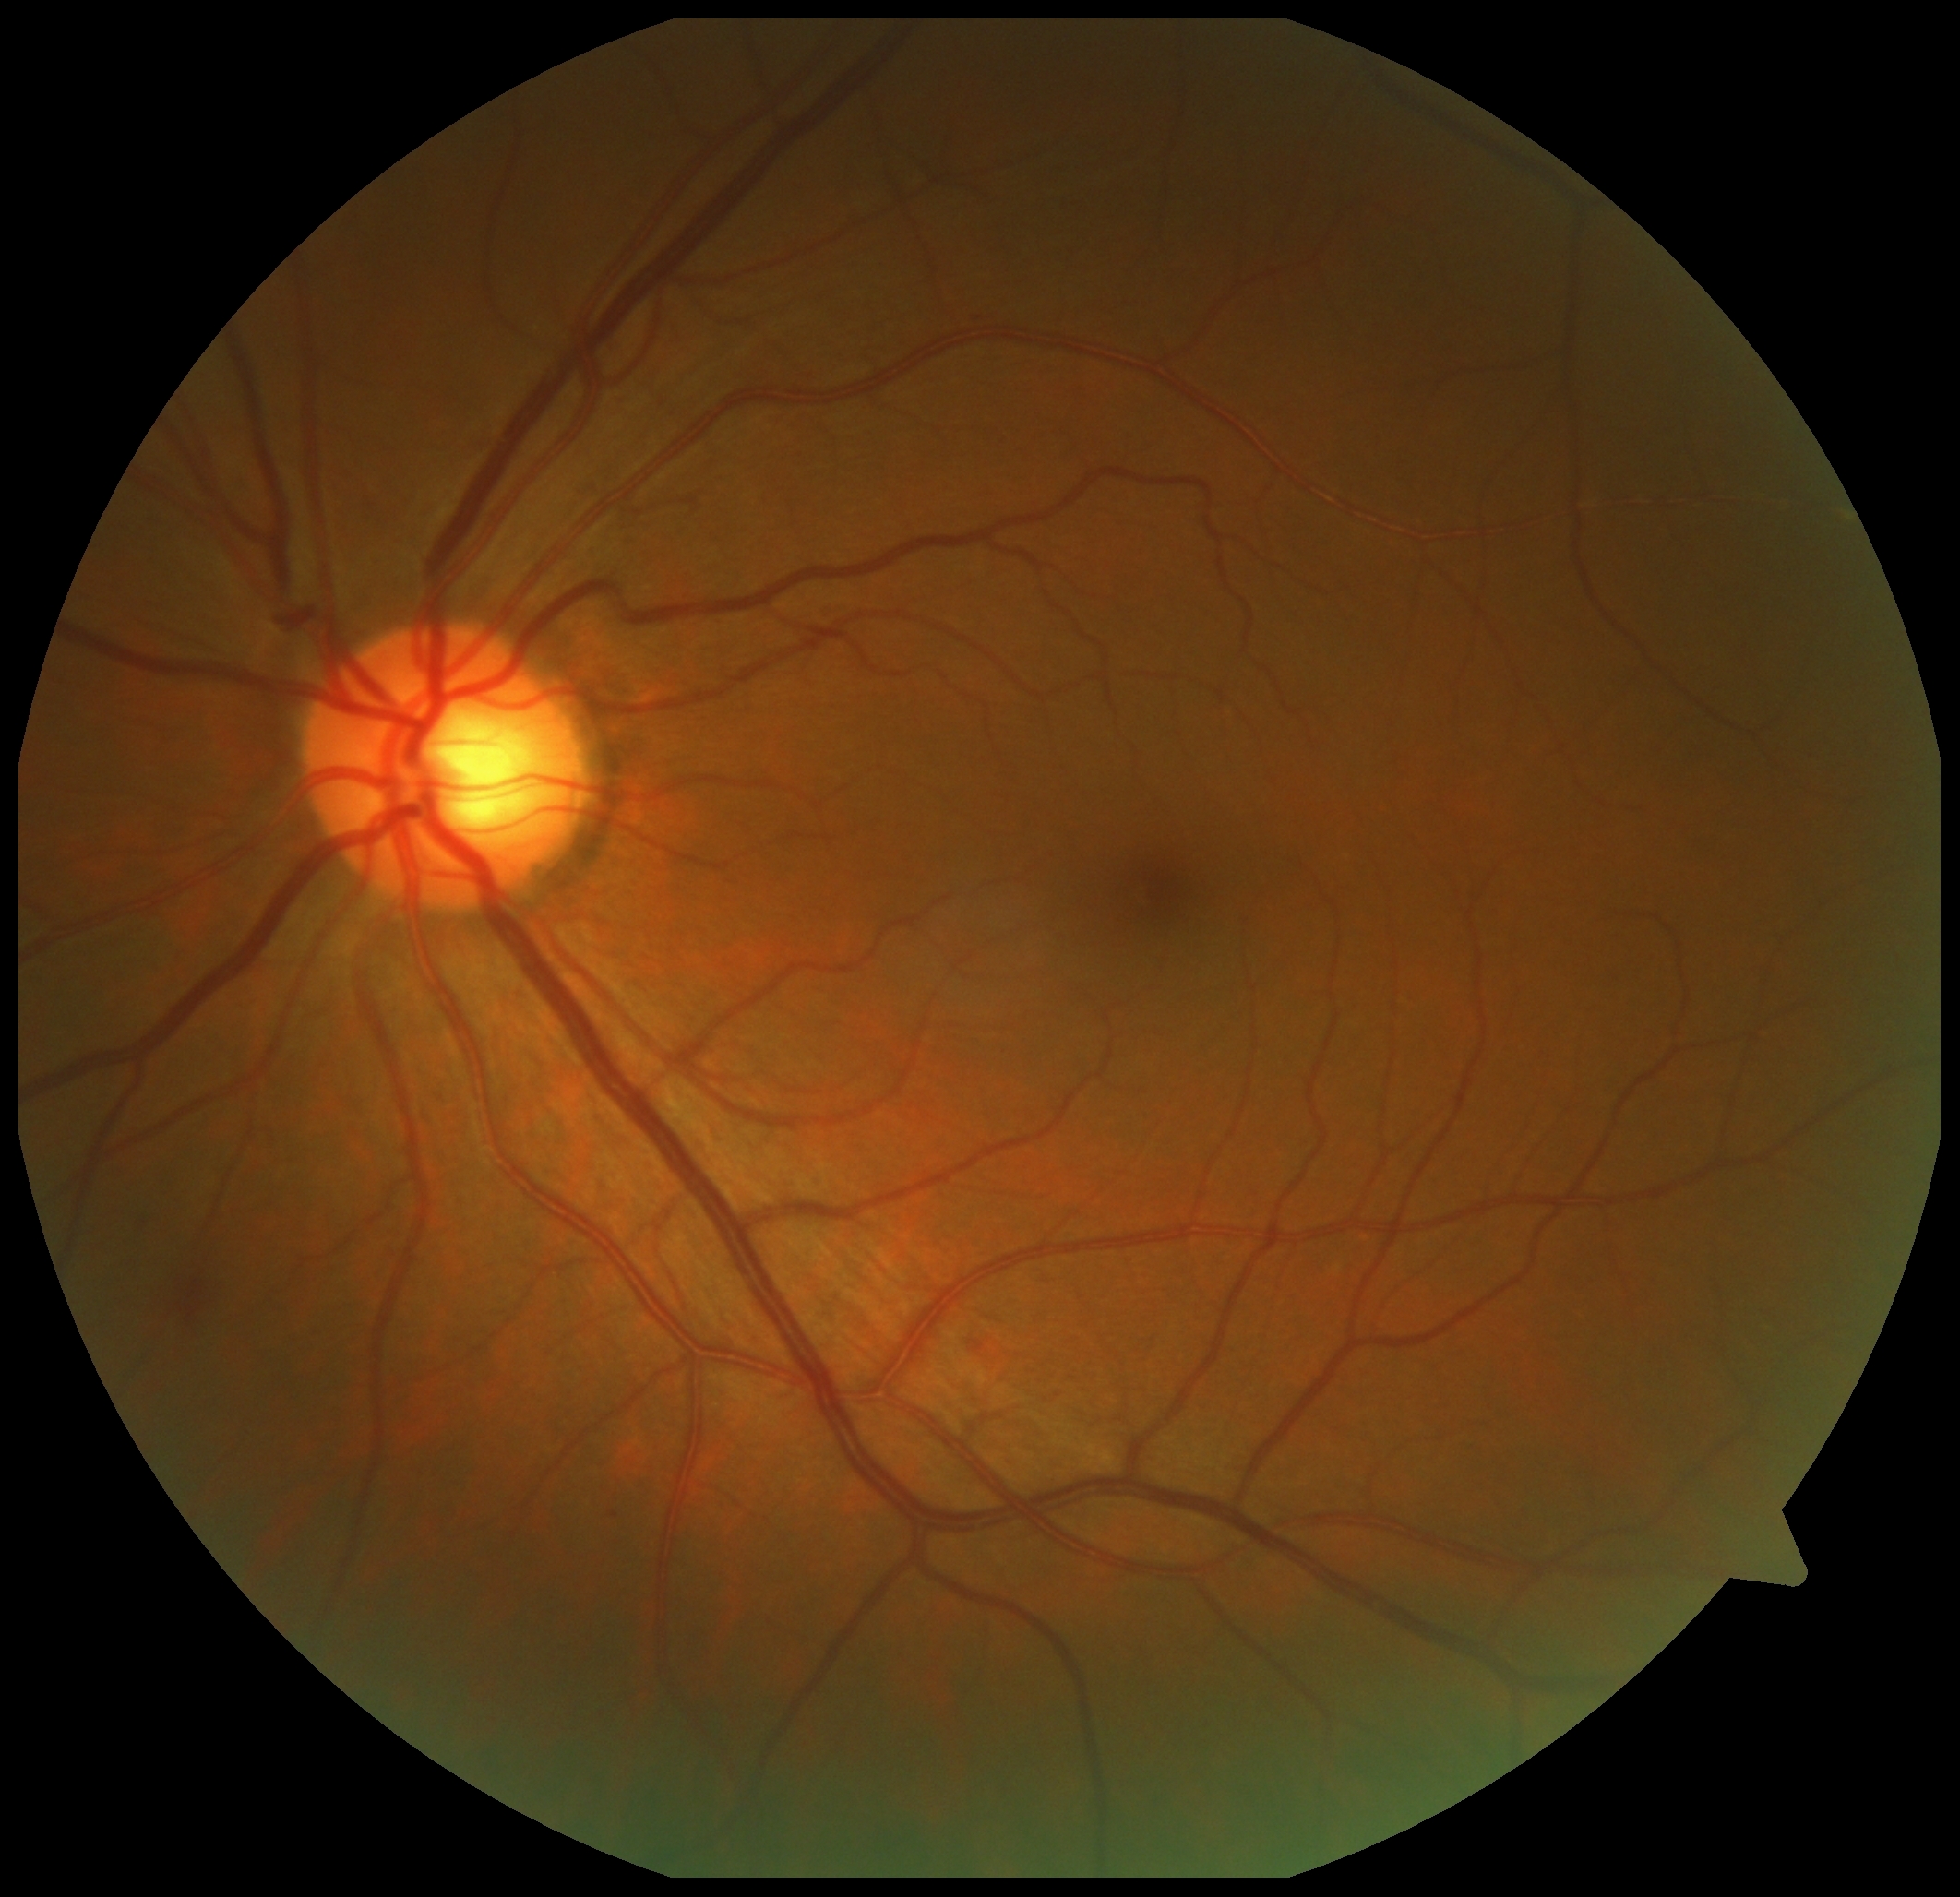 {
  "dr_grade": "grade 2"
}